45-degree field of view. 848x848px.
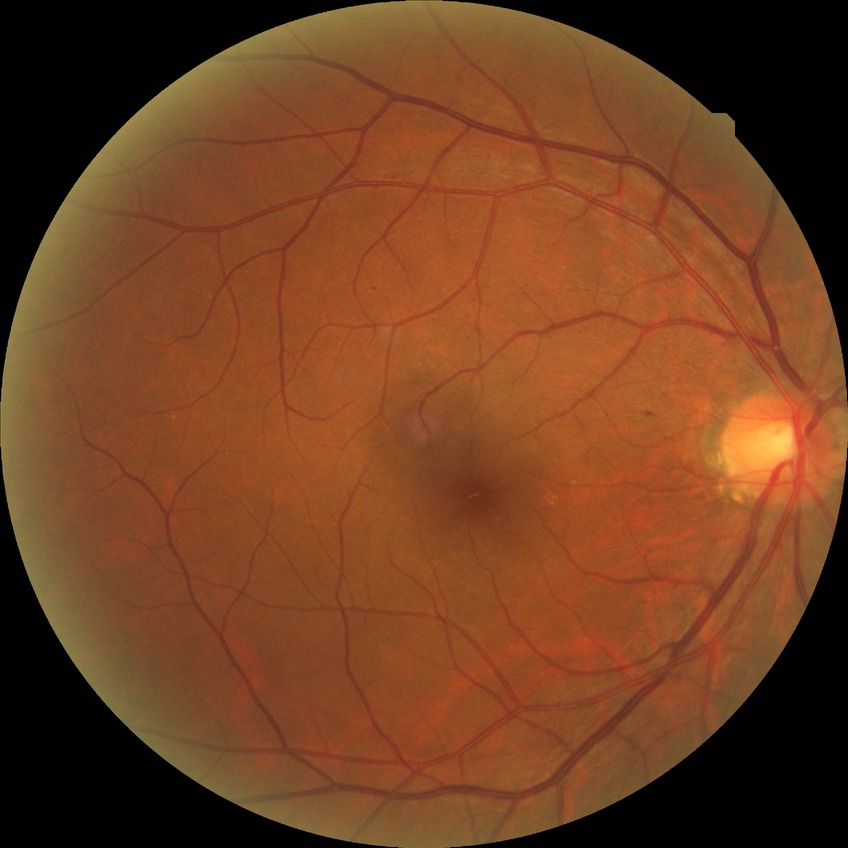

DR is SDR.